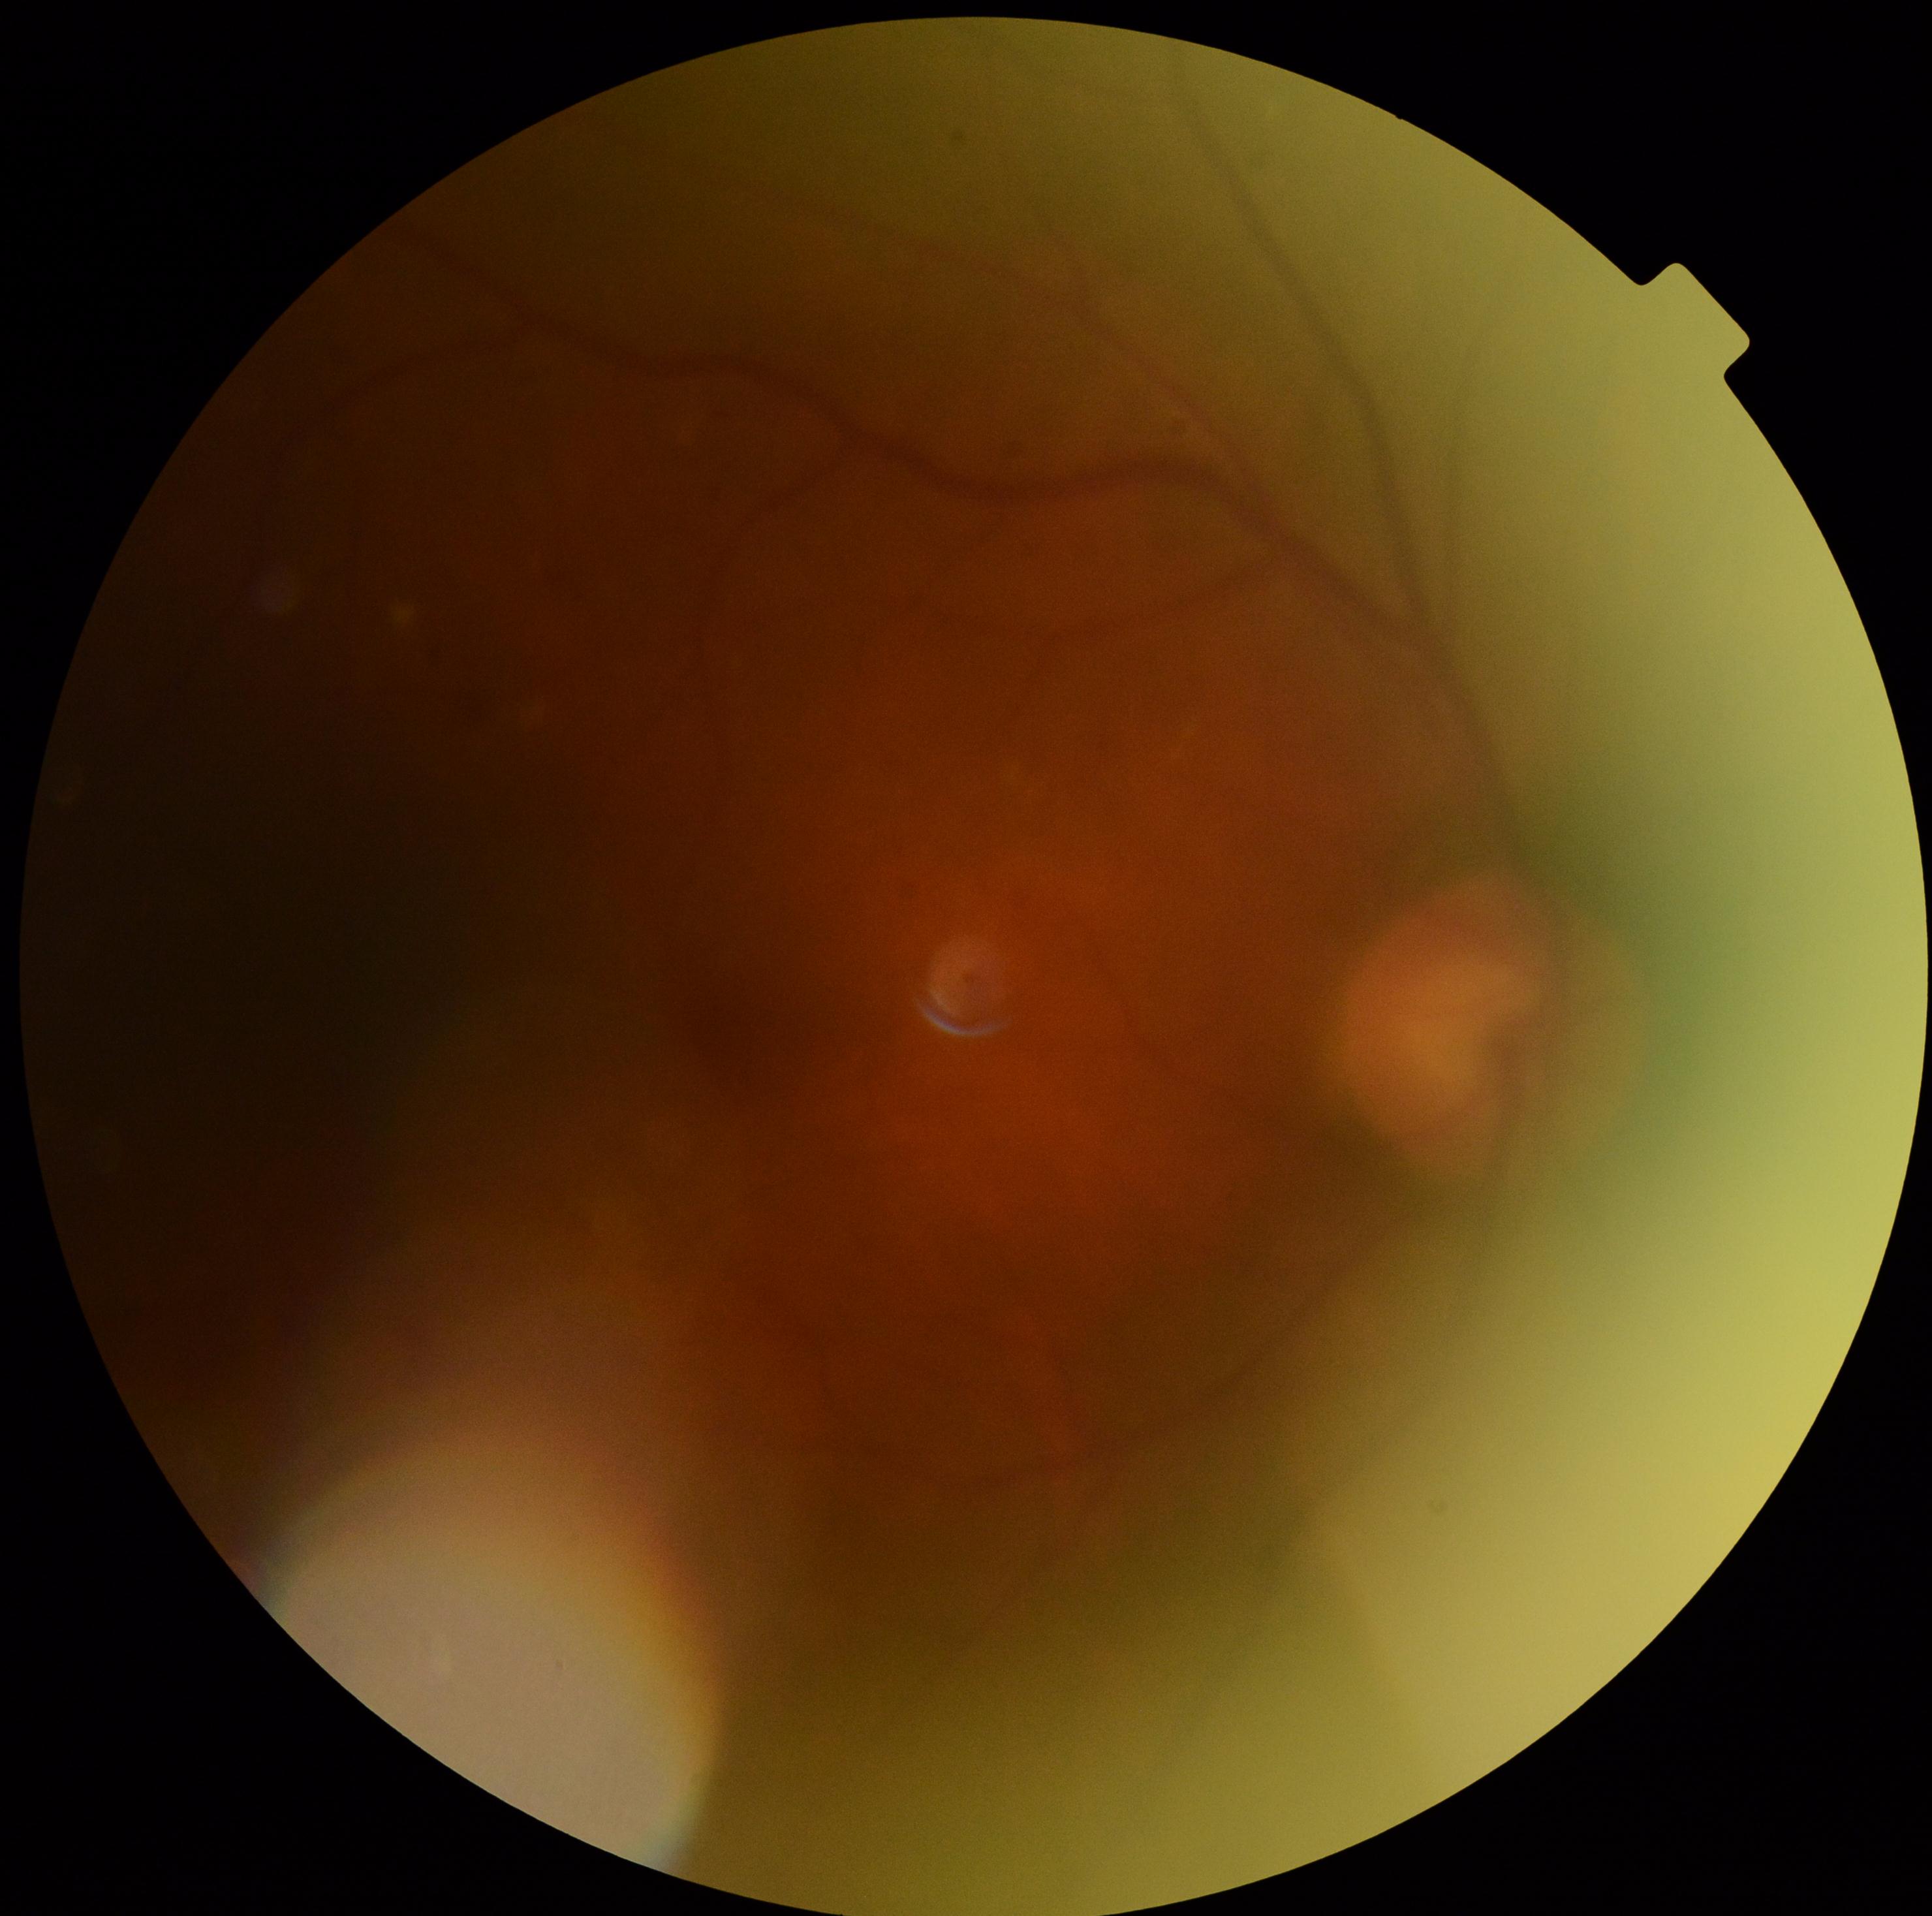

Diabetic retinopathy severity: grade 0 (no apparent retinopathy).